Retinal fundus photograph, 45° FOV — 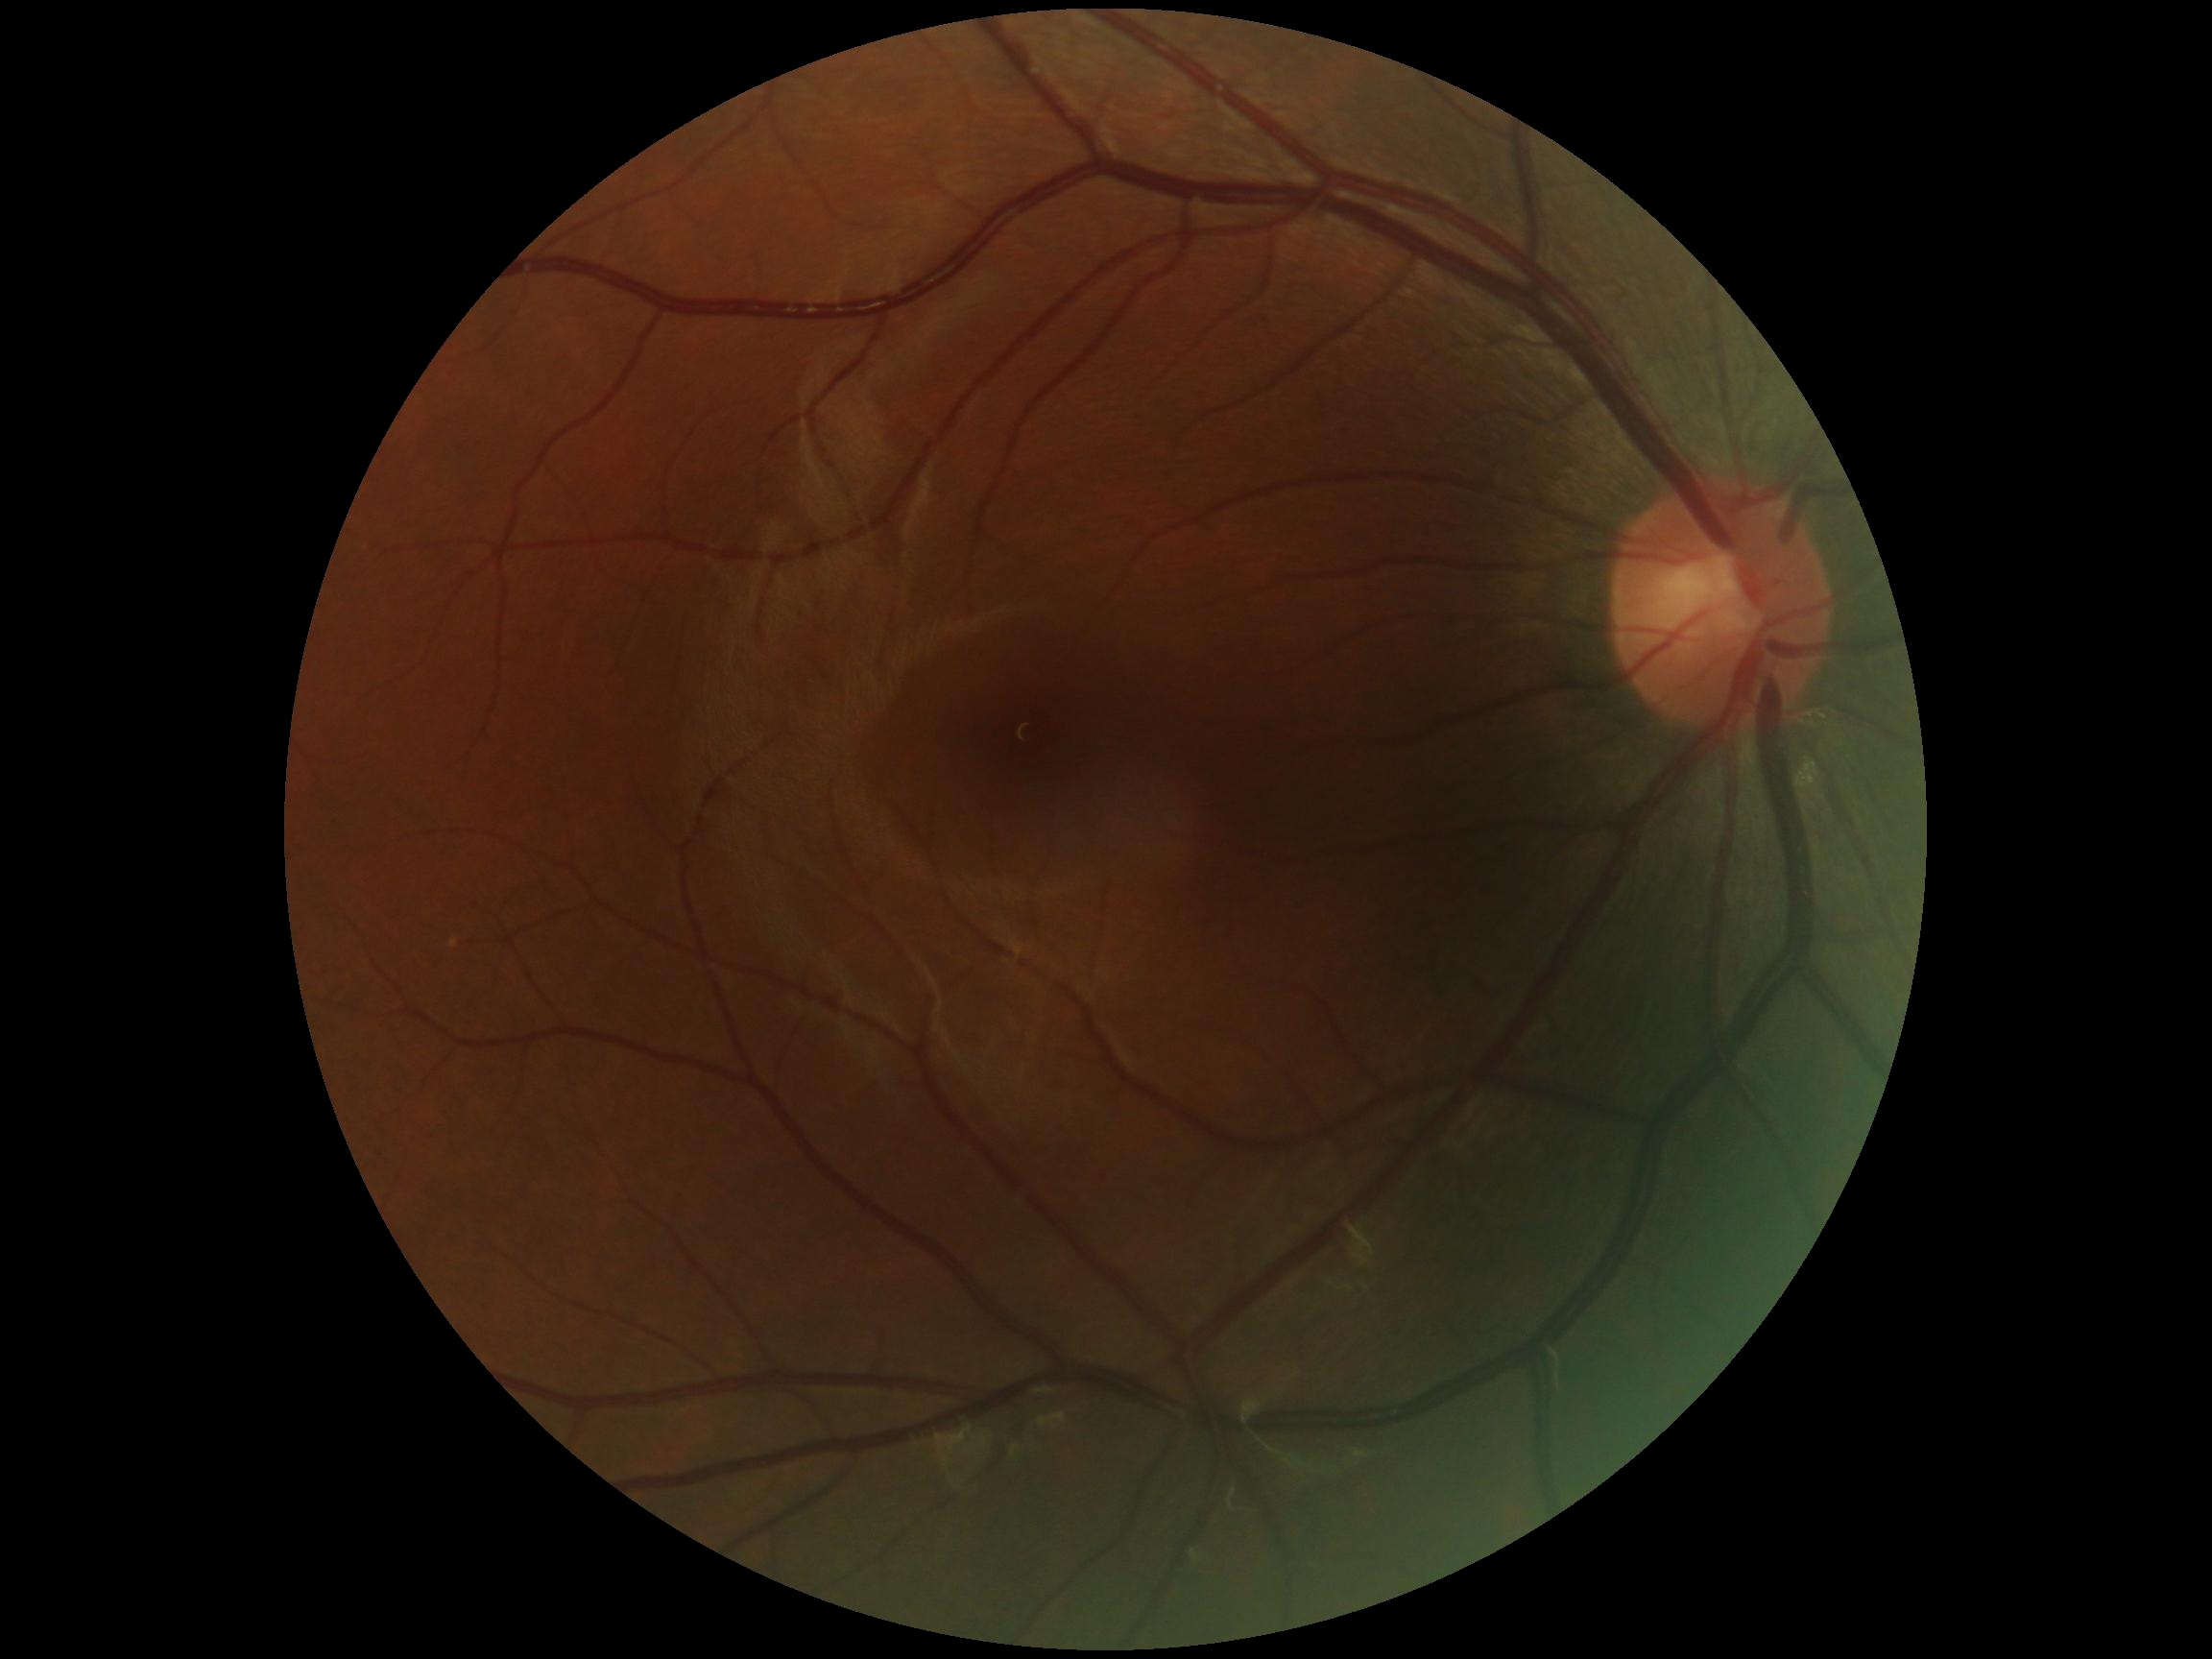 diabetic retinopathy severity=0/4.